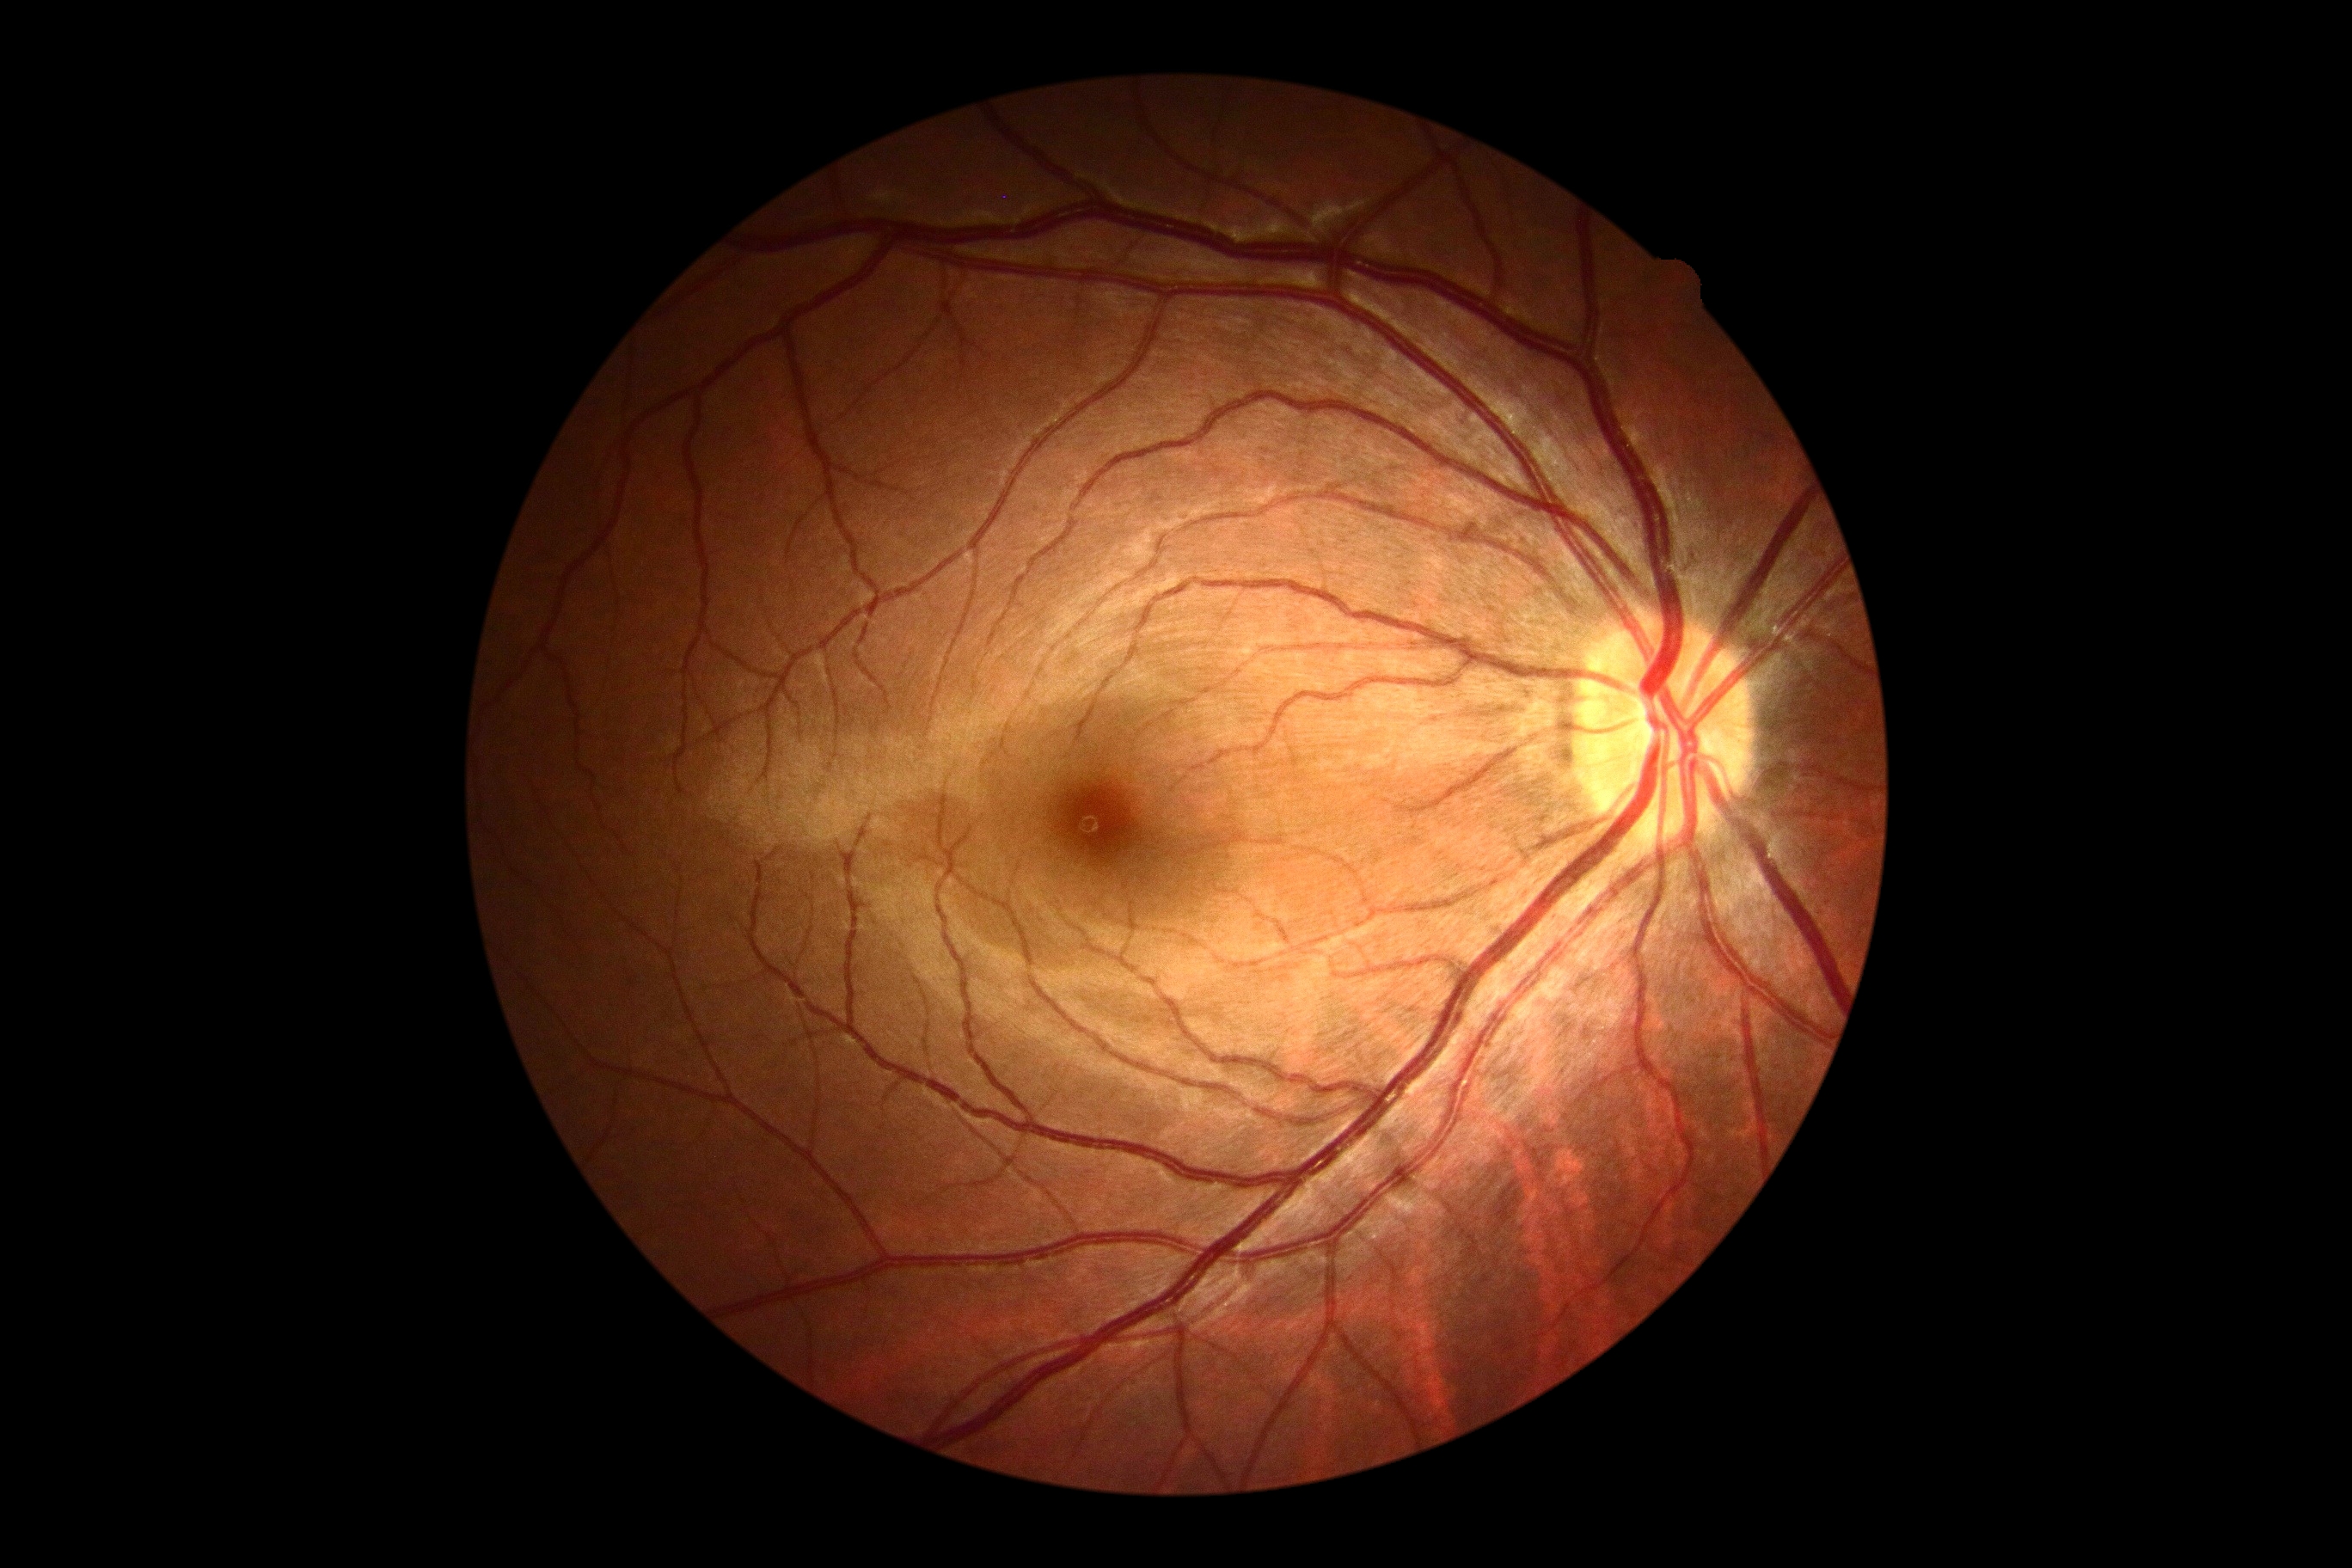 No signs of diabetic retinopathy. Diabetic retinopathy grade: no apparent diabetic retinopathy (0).